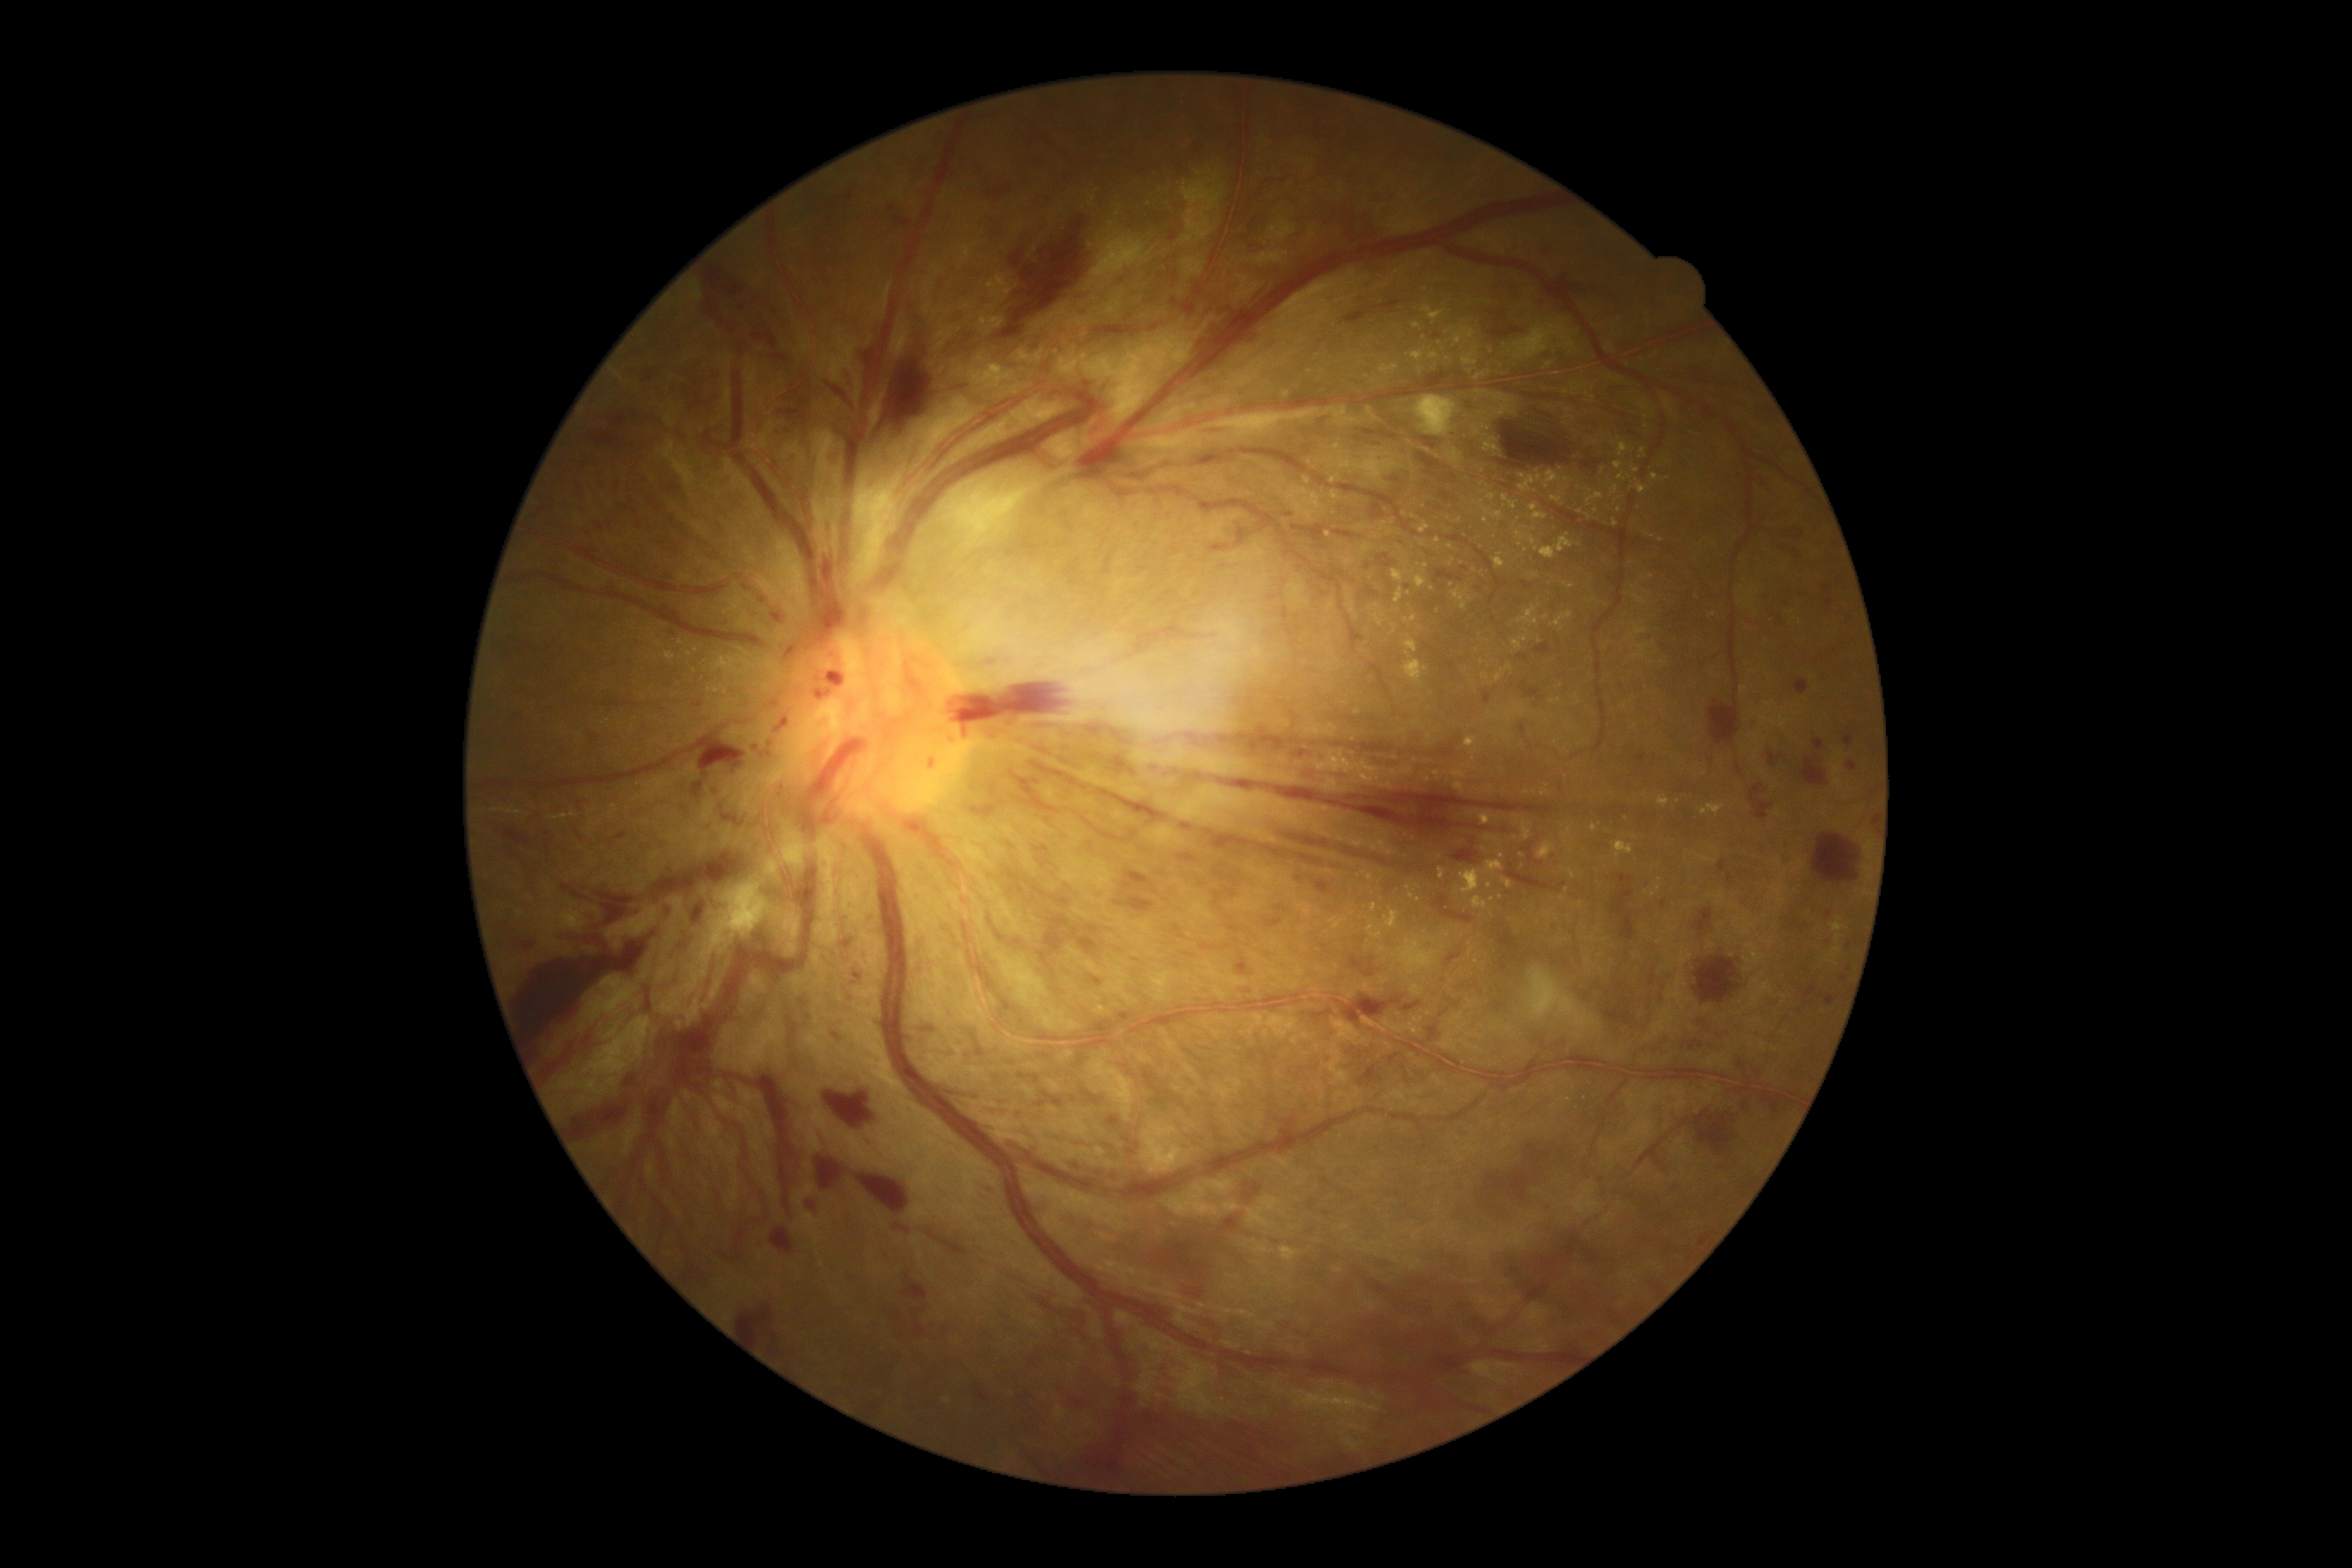
Diabetic retinopathy (DR) is PDR (grade 4) — neovascularization and/or vitreous/pre-retinal hemorrhage
Representative lesions:
hard exudates (EXs) (partial): (x1=1519, y1=470, x2=1543, y2=493), (x1=1449, y1=558, x2=1455, y2=567), (x1=1430, y1=353, x2=1440, y2=360), (x1=1395, y1=587, x2=1402, y2=604), (x1=1373, y1=613, x2=1385, y2=628), (x1=1657, y1=940, x2=1665, y2=945), (x1=1658, y1=797, x2=1670, y2=809), (x1=1538, y1=842, x2=1557, y2=859), (x1=1433, y1=771, x2=1442, y2=781), (x1=1521, y1=819, x2=1531, y2=842)
EXs (small, approximate centers) near [x=1554, y=1107], [x=1593, y=600], [x=1486, y=429], [x=1560, y=700], [x=1427, y=566], [x=1419, y=900], [x=1331, y=458], [x=1663, y=663], [x=1357, y=712], [x=1452, y=585]
hemorrhages (HEs) (partial): (x1=1335, y1=995, x2=1402, y2=1026), (x1=1749, y1=783, x2=1773, y2=821), (x1=1521, y1=683, x2=1543, y2=701), (x1=1120, y1=1014, x2=1130, y2=1022), (x1=687, y1=1032, x2=713, y2=1058), (x1=1309, y1=1201, x2=1318, y2=1210), (x1=1173, y1=926, x2=1187, y2=940), (x1=1387, y1=477, x2=1400, y2=481), (x1=1235, y1=955, x2=1249, y2=977), (x1=1321, y1=1179, x2=1330, y2=1185), (x1=1187, y1=775, x2=1203, y2=781), (x1=1428, y1=1027, x2=1438, y2=1041), (x1=1351, y1=955, x2=1366, y2=972), (x1=685, y1=372, x2=721, y2=415), (x1=989, y1=212, x2=1099, y2=343), (x1=558, y1=885, x2=591, y2=900), (x1=830, y1=1031, x2=843, y2=1043), (x1=713, y1=264, x2=725, y2=283)
HEs (small, approximate centers) near [x=1458, y=1004]